Pupil-dilated.
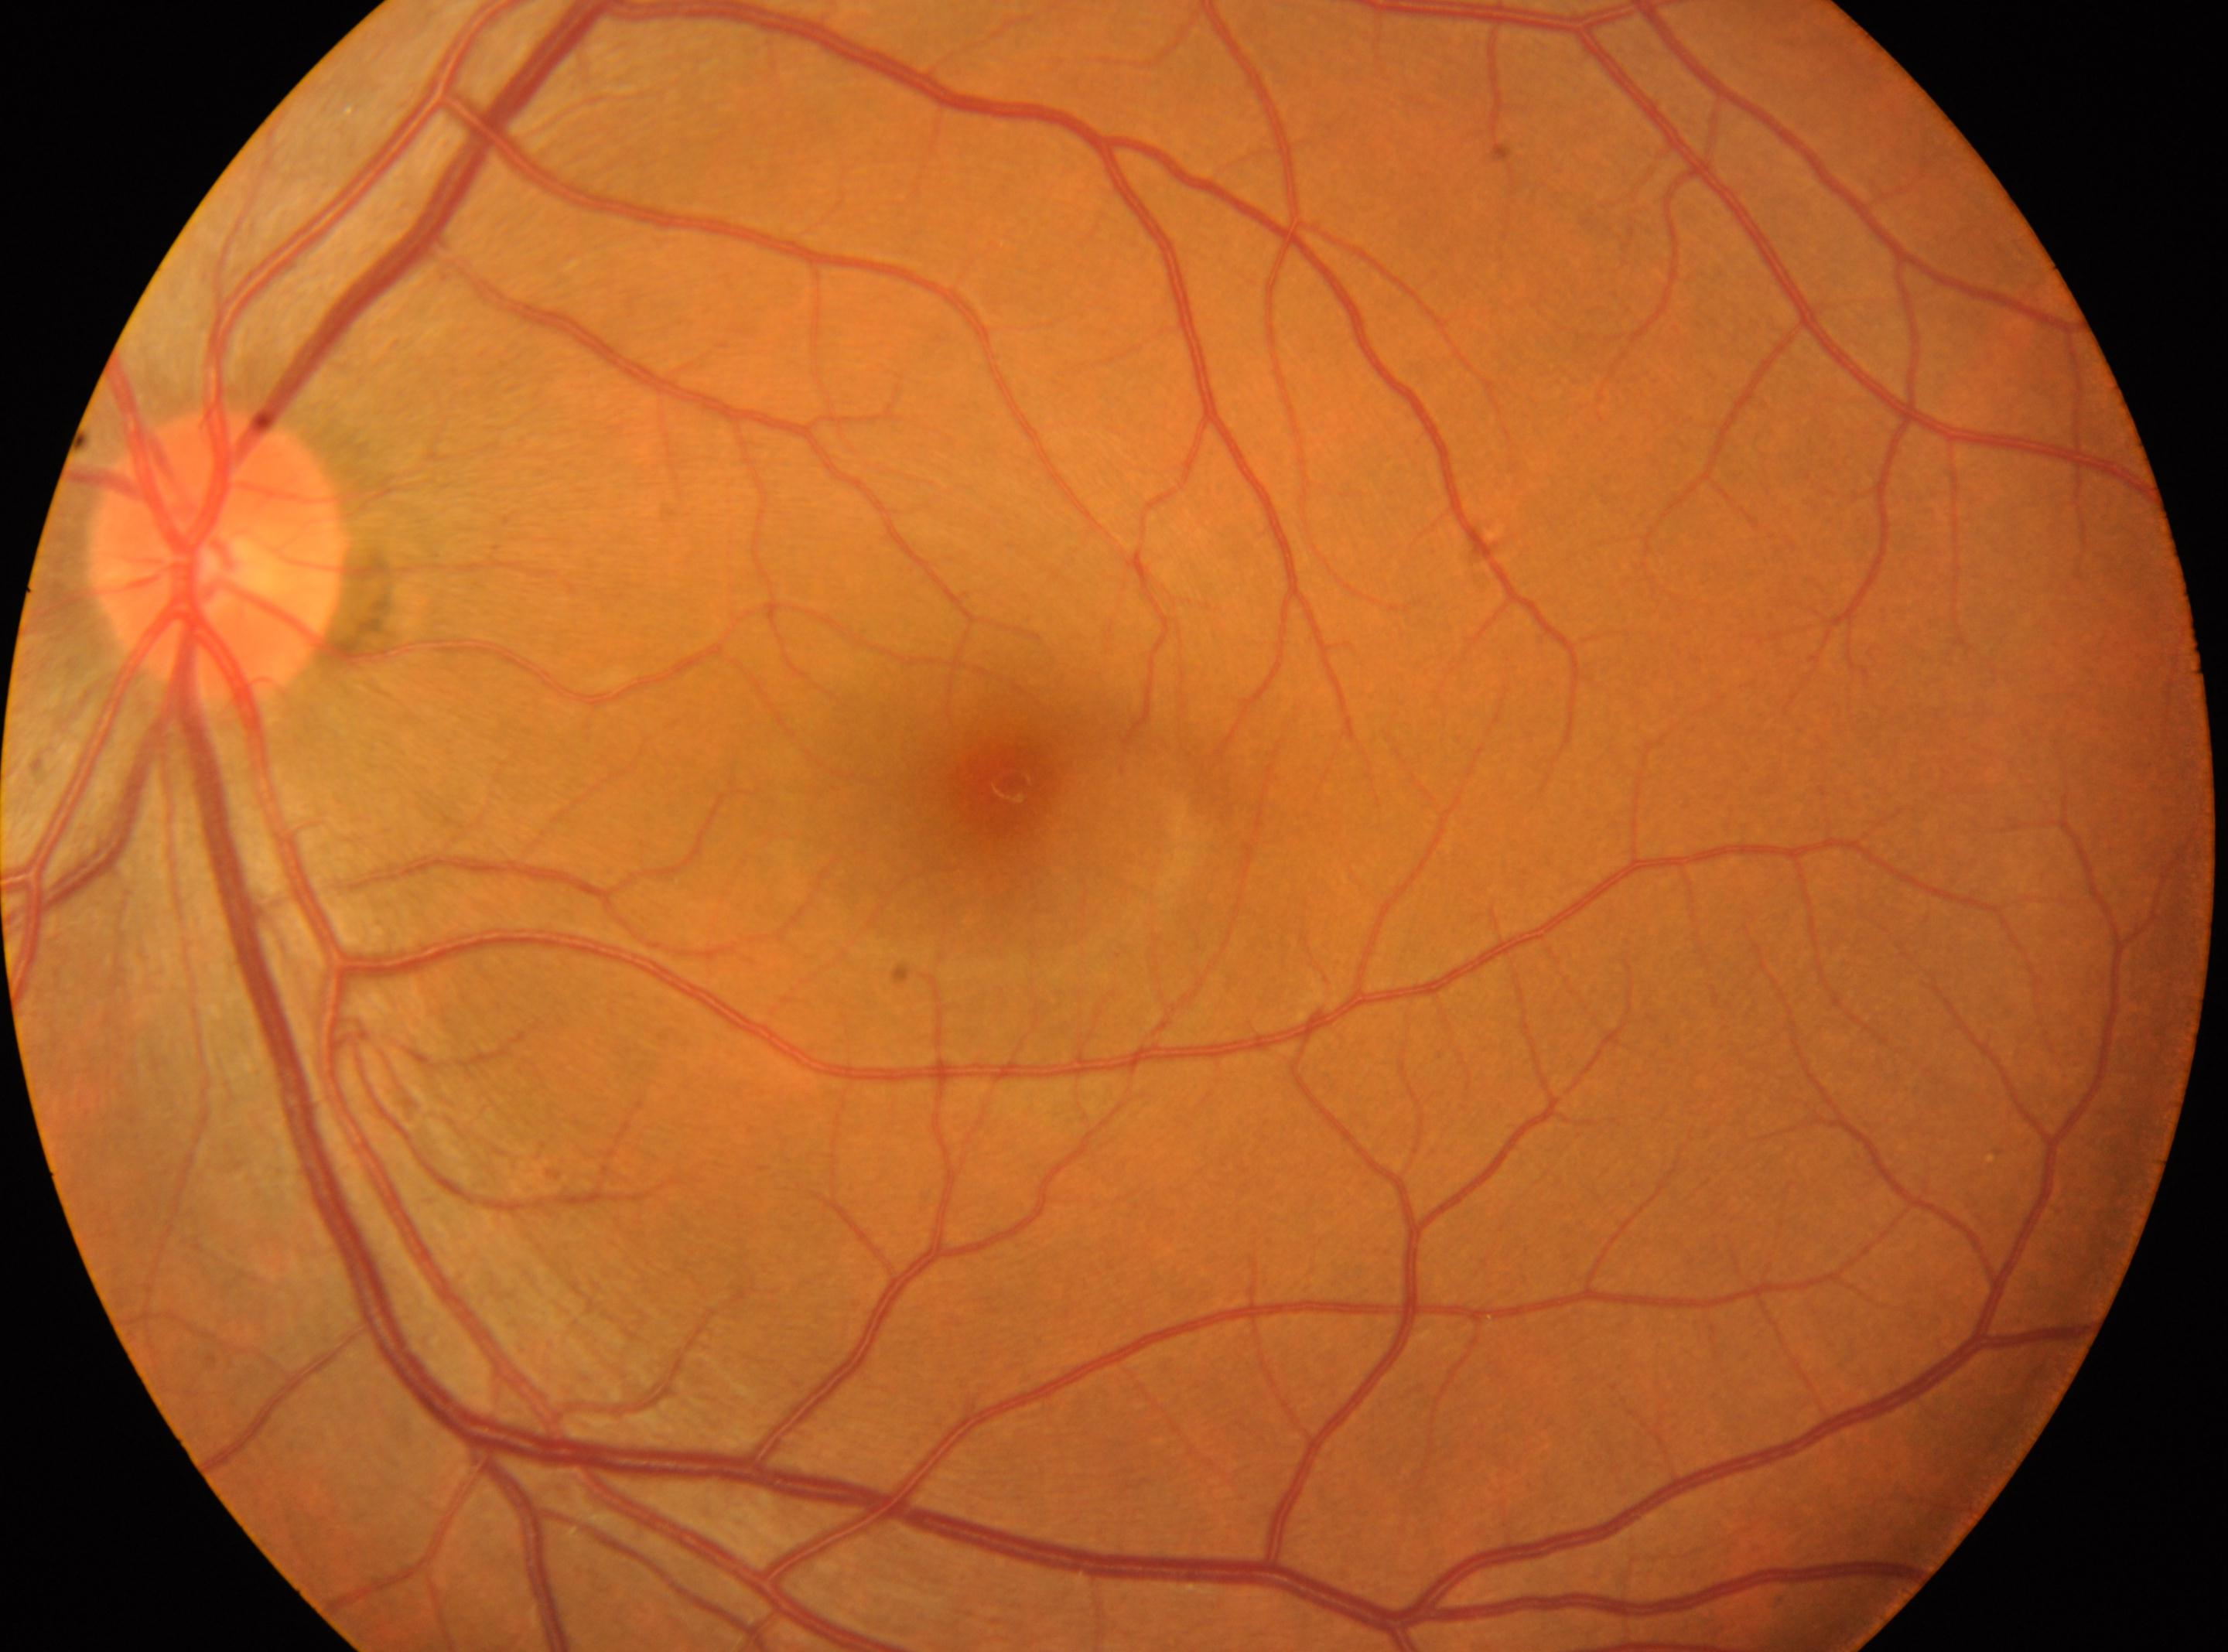 The fovea is at 1010px, 783px. Diabetic retinopathy (DR) is no apparent retinopathy (grade 0). No signs of diabetic retinopathy. Optic nerve head: 217px, 554px. The image shows the left eye.